2352 x 1568 pixels
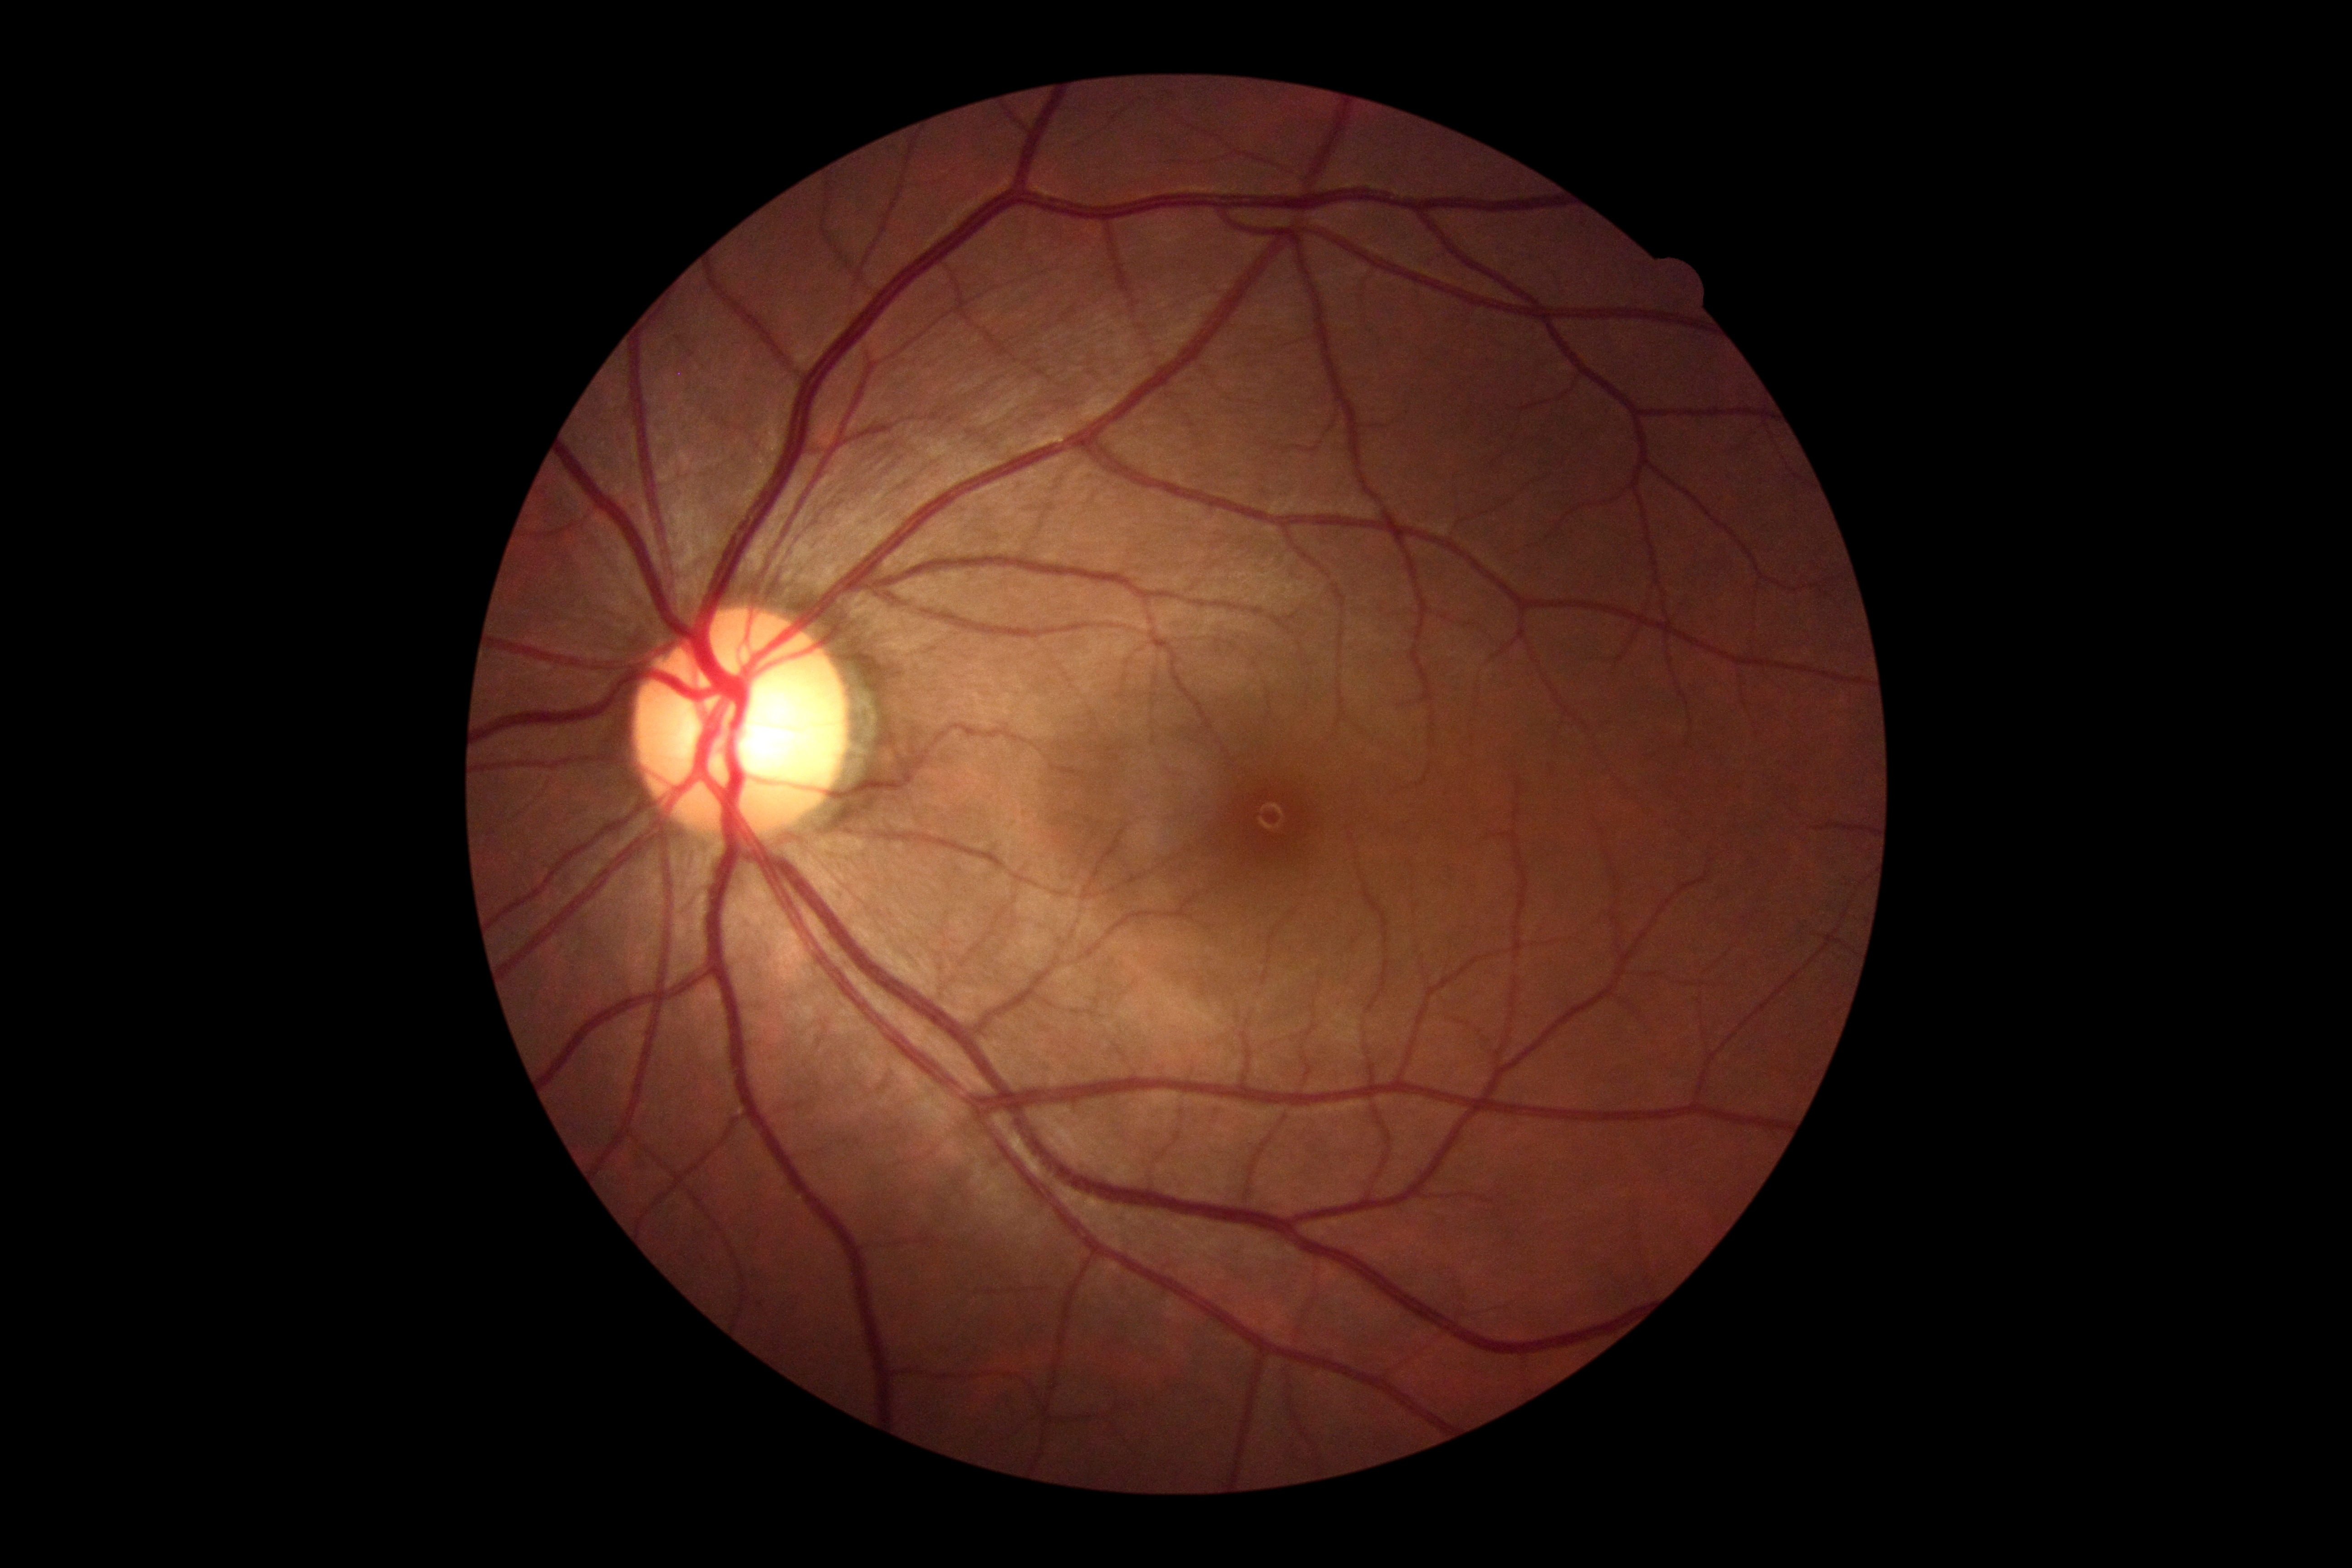
Retinopathy is 0/4.